Color fundus photograph: 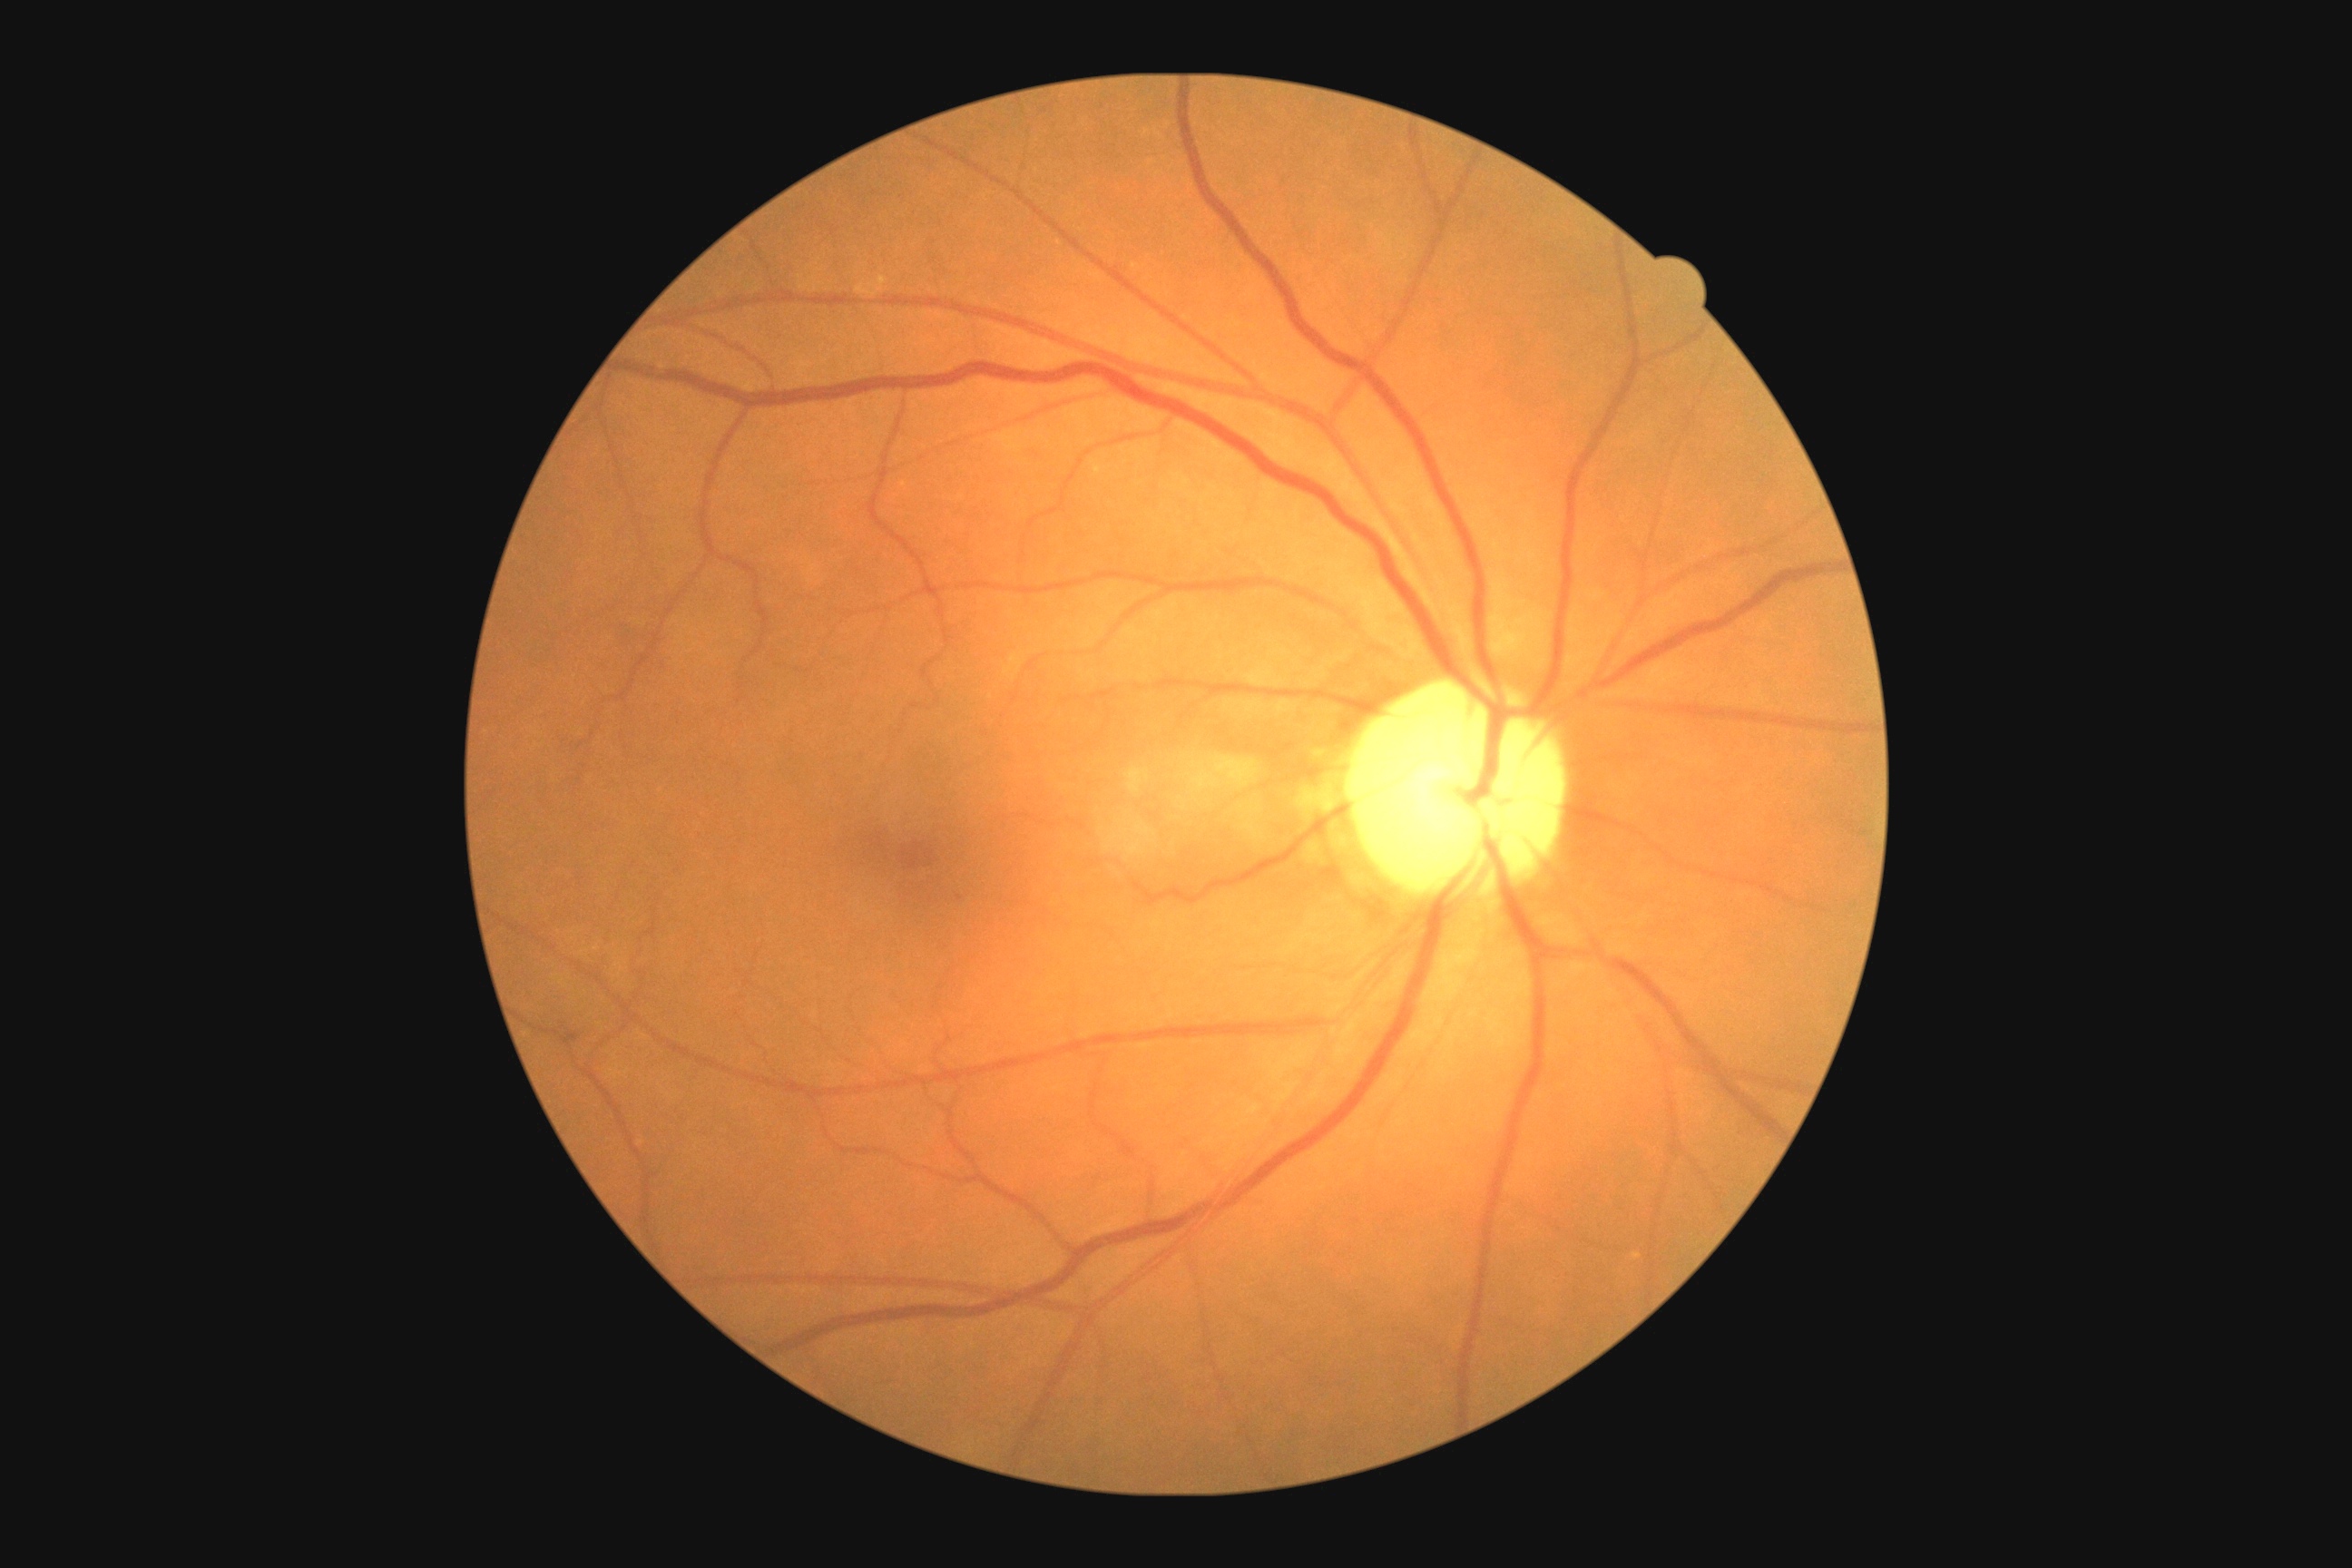 Diabetic retinopathy grade: 1 (mild NPDR).